2048 x 1536 pixels · CFP:
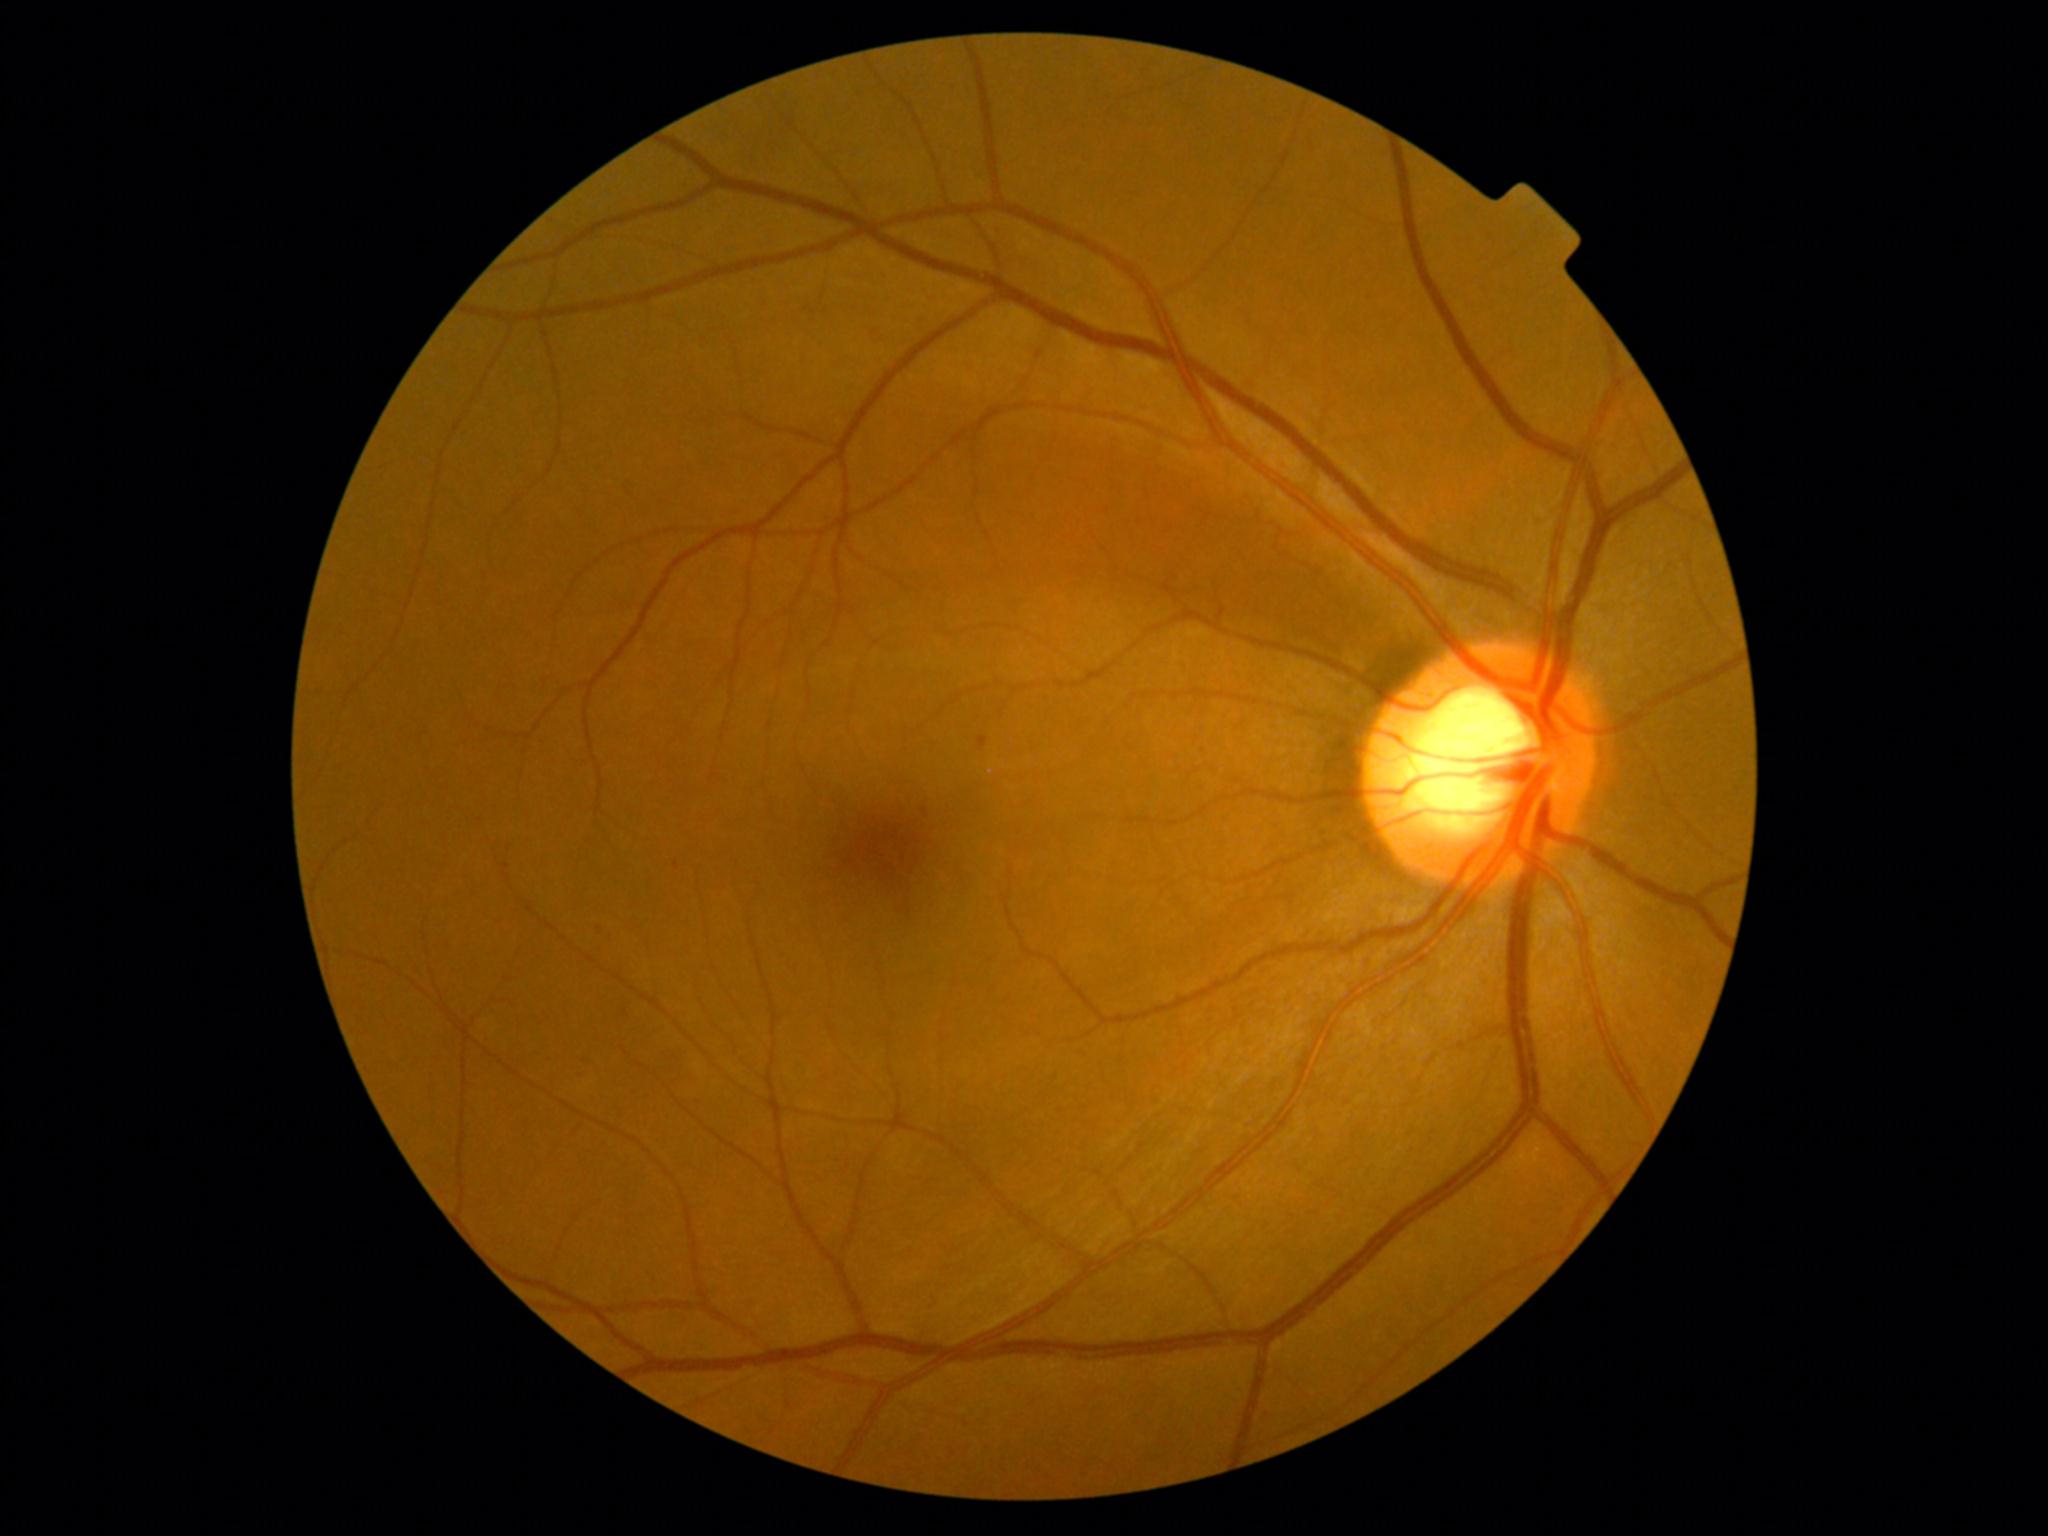 DR is grade 1 (mild NPDR).